Wide-field fundus photograph of an infant · 640x480: 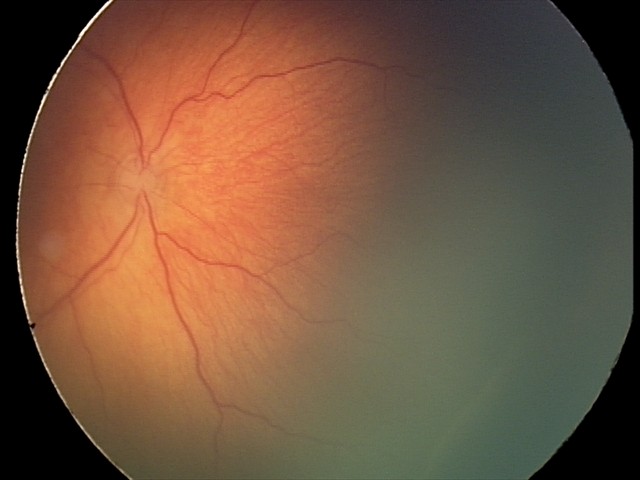 No plus disease. Screening series with ROP stage 2.